Color fundus photograph, FOV: 45 degrees, 2212x1659 — 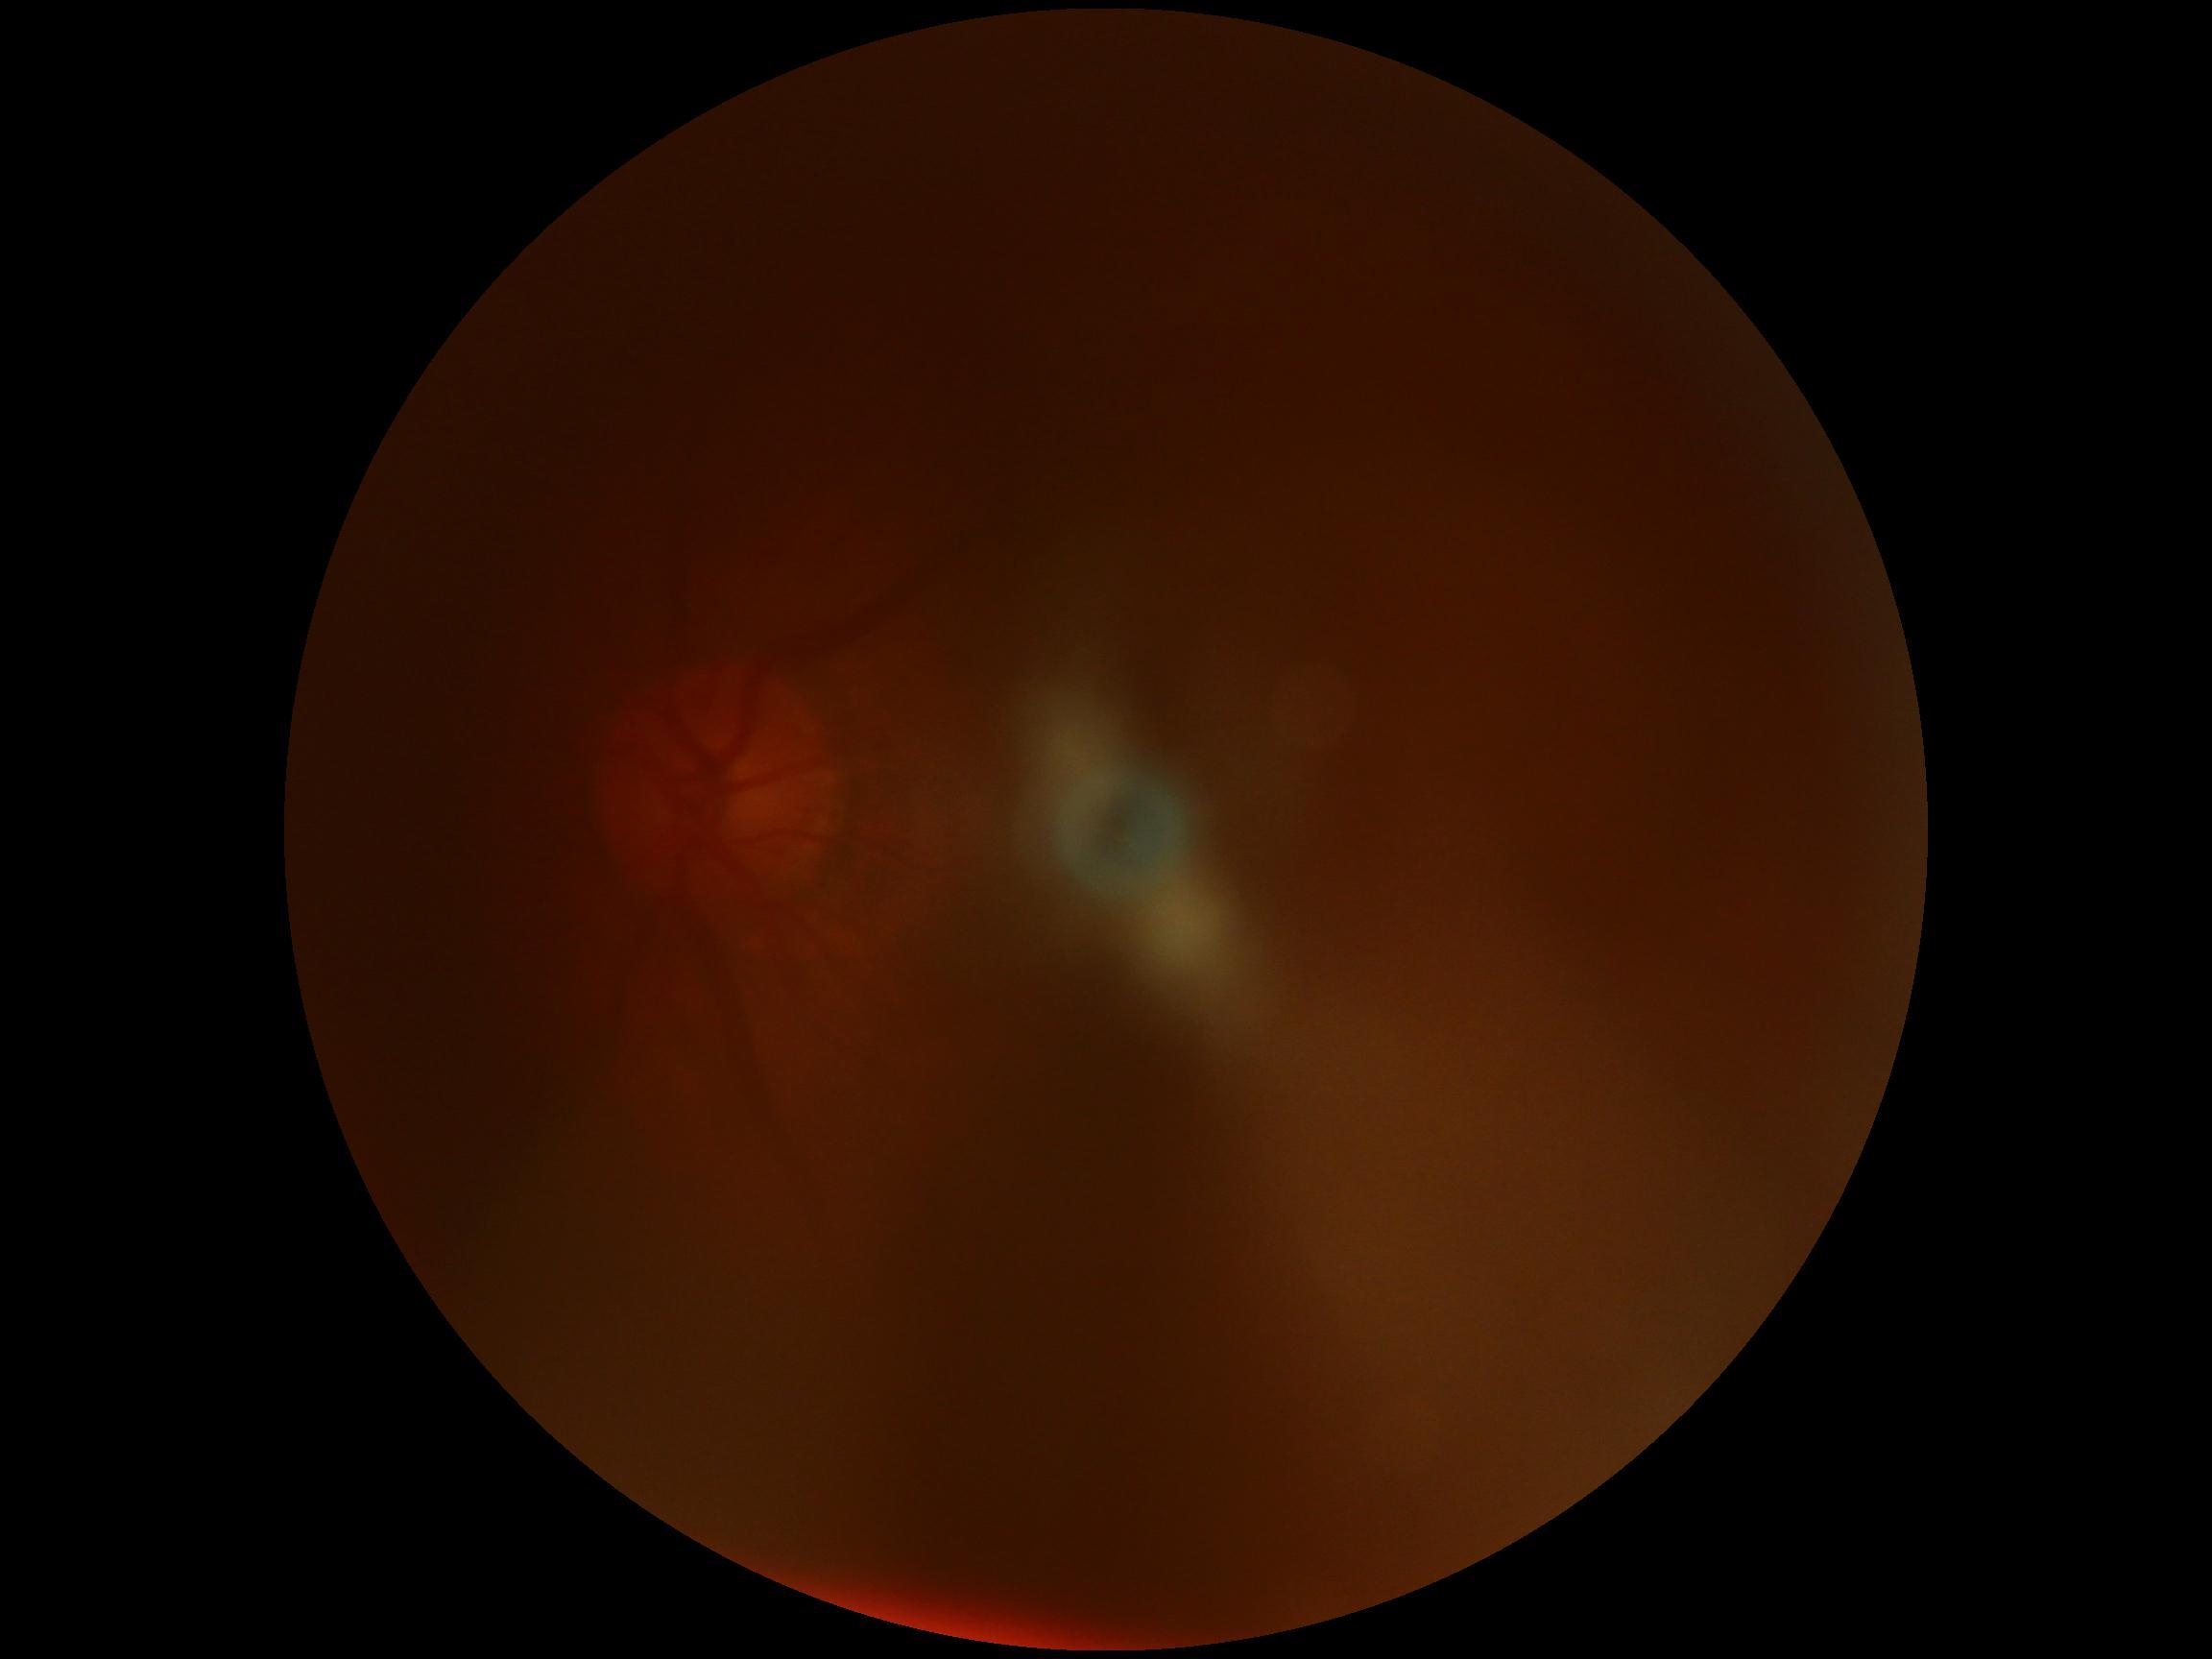 Diabetic retinopathy (DR) is ungradable.